DR severity per modified Davis staging · 45° field of view — 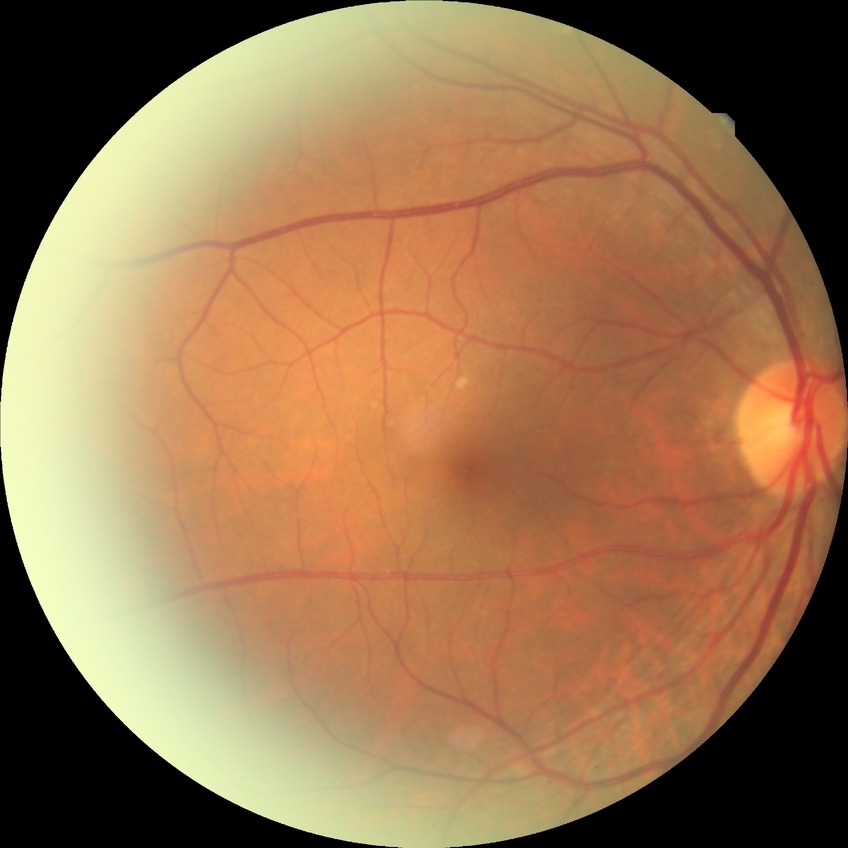
• DR grade: NDR
• DR impression: no apparent DR